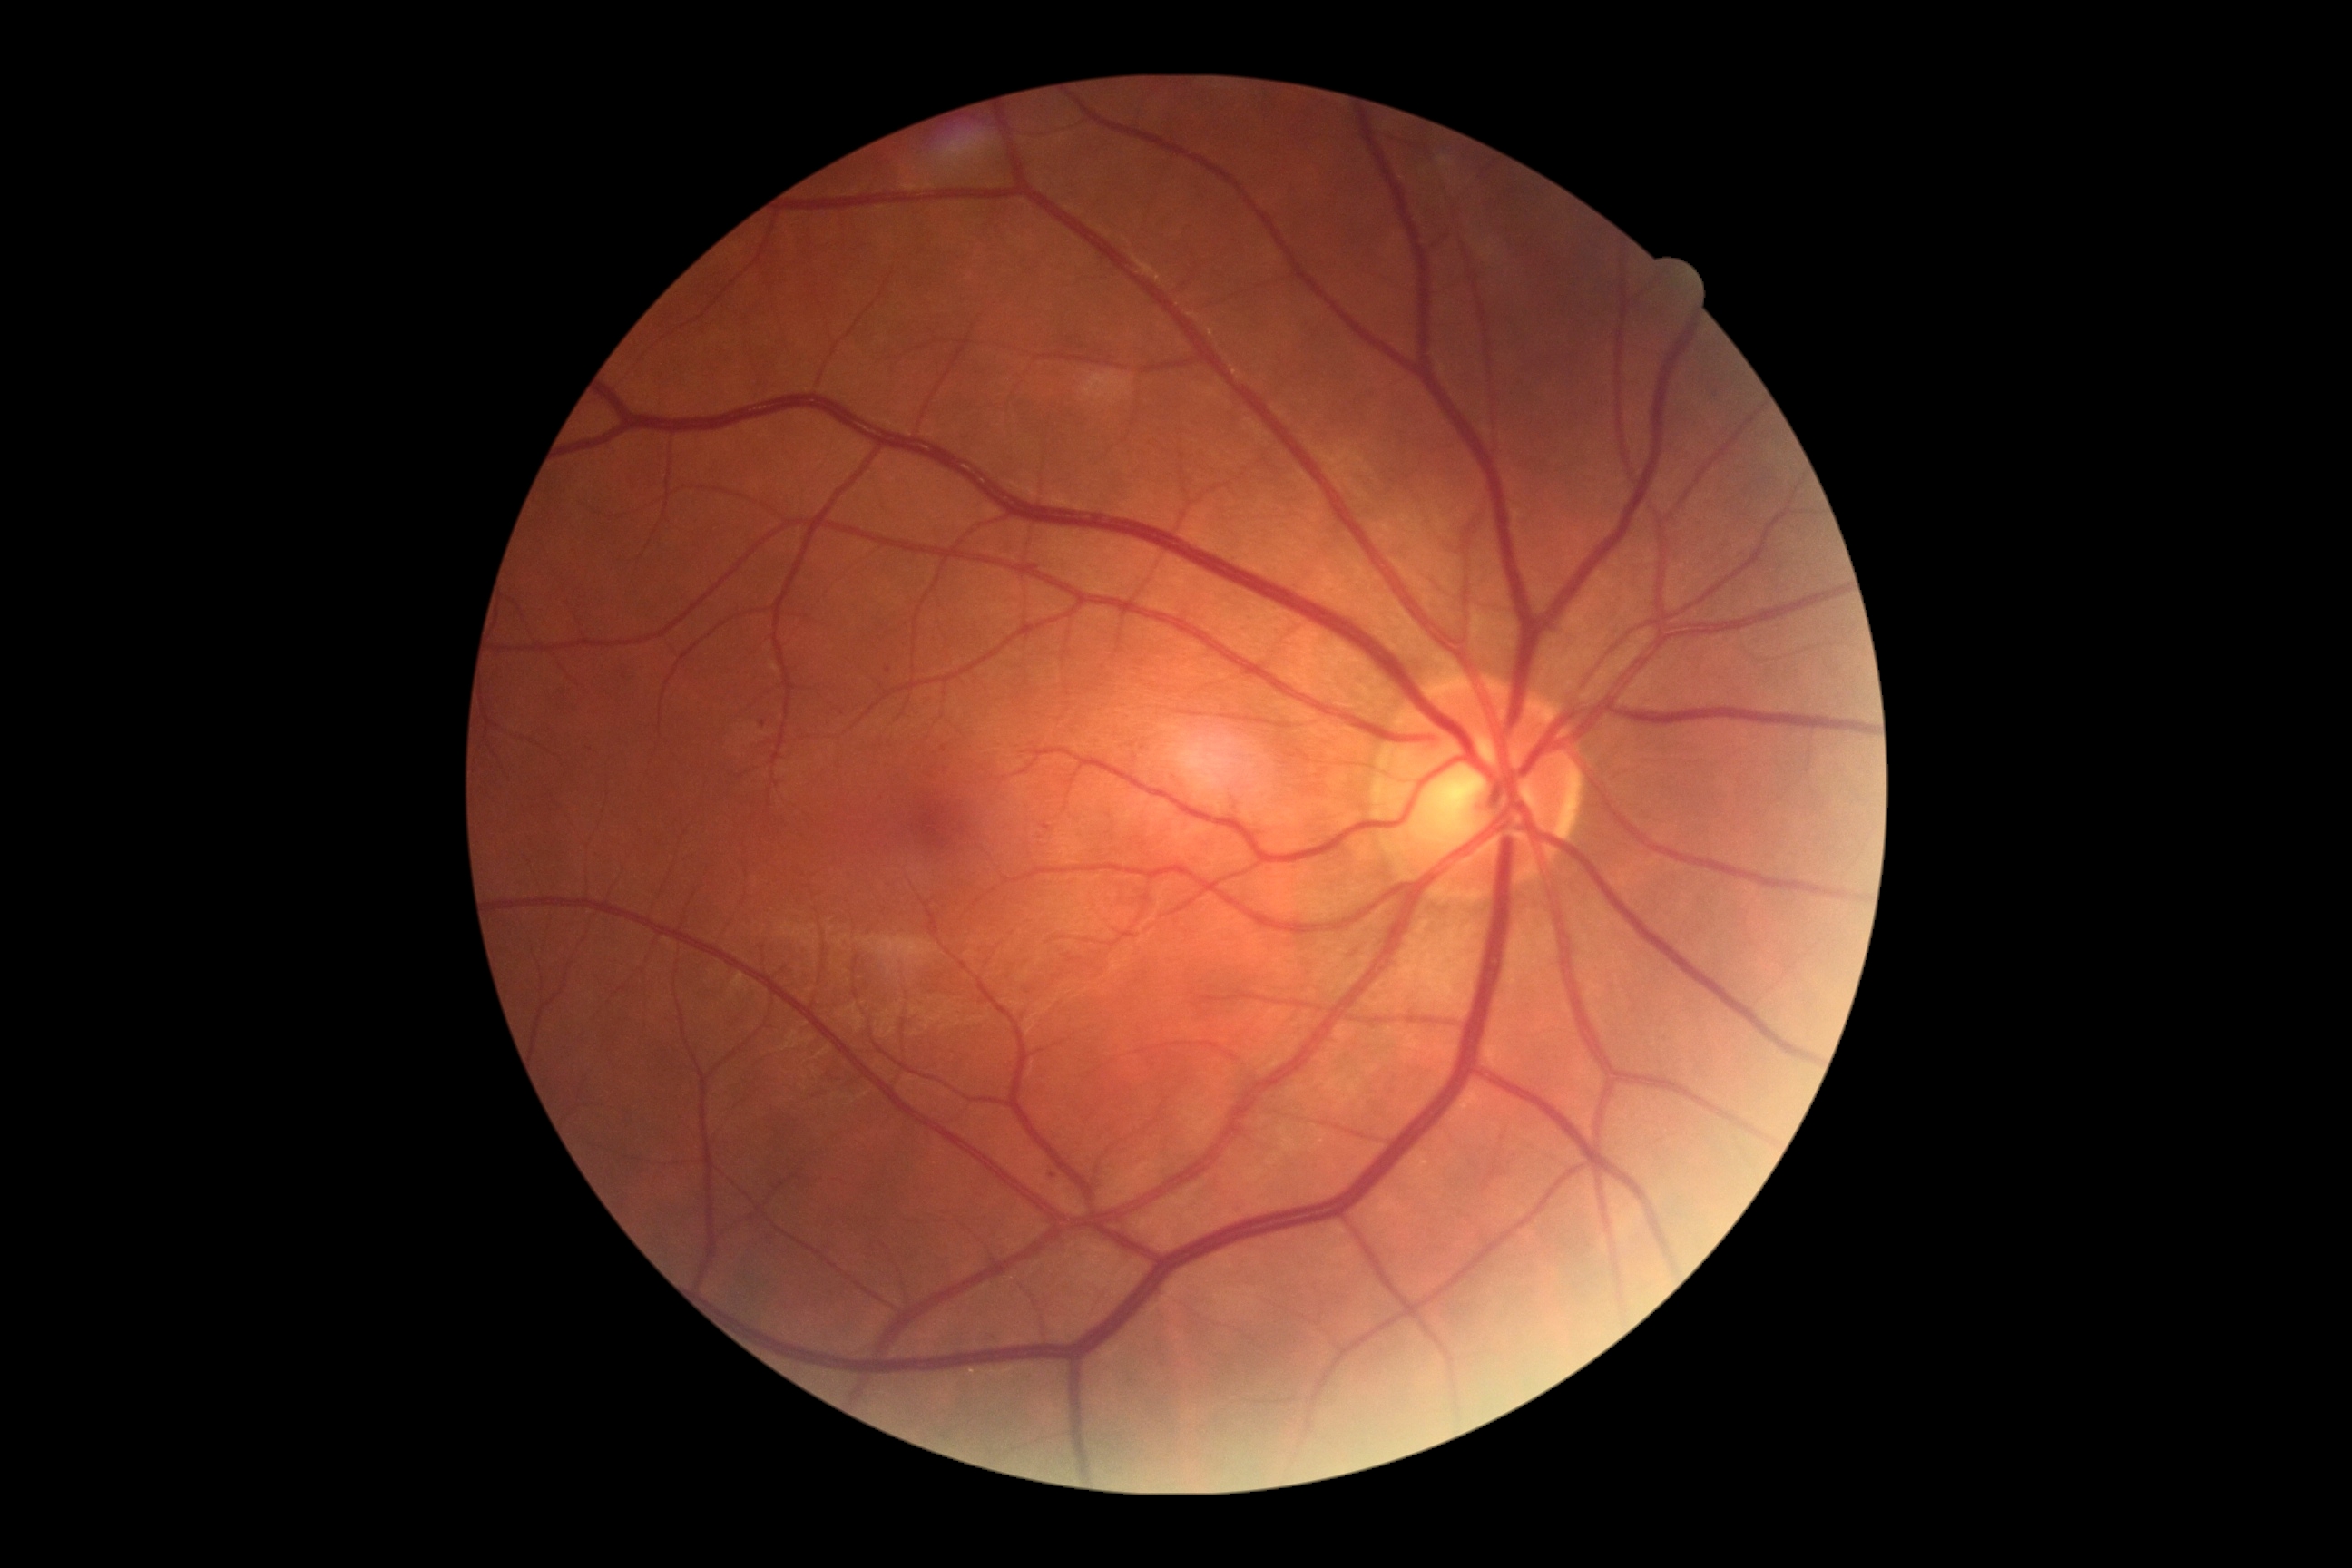

DR severity=mild non-proliferative diabetic retinopathy (grade 1).